45° field of view: 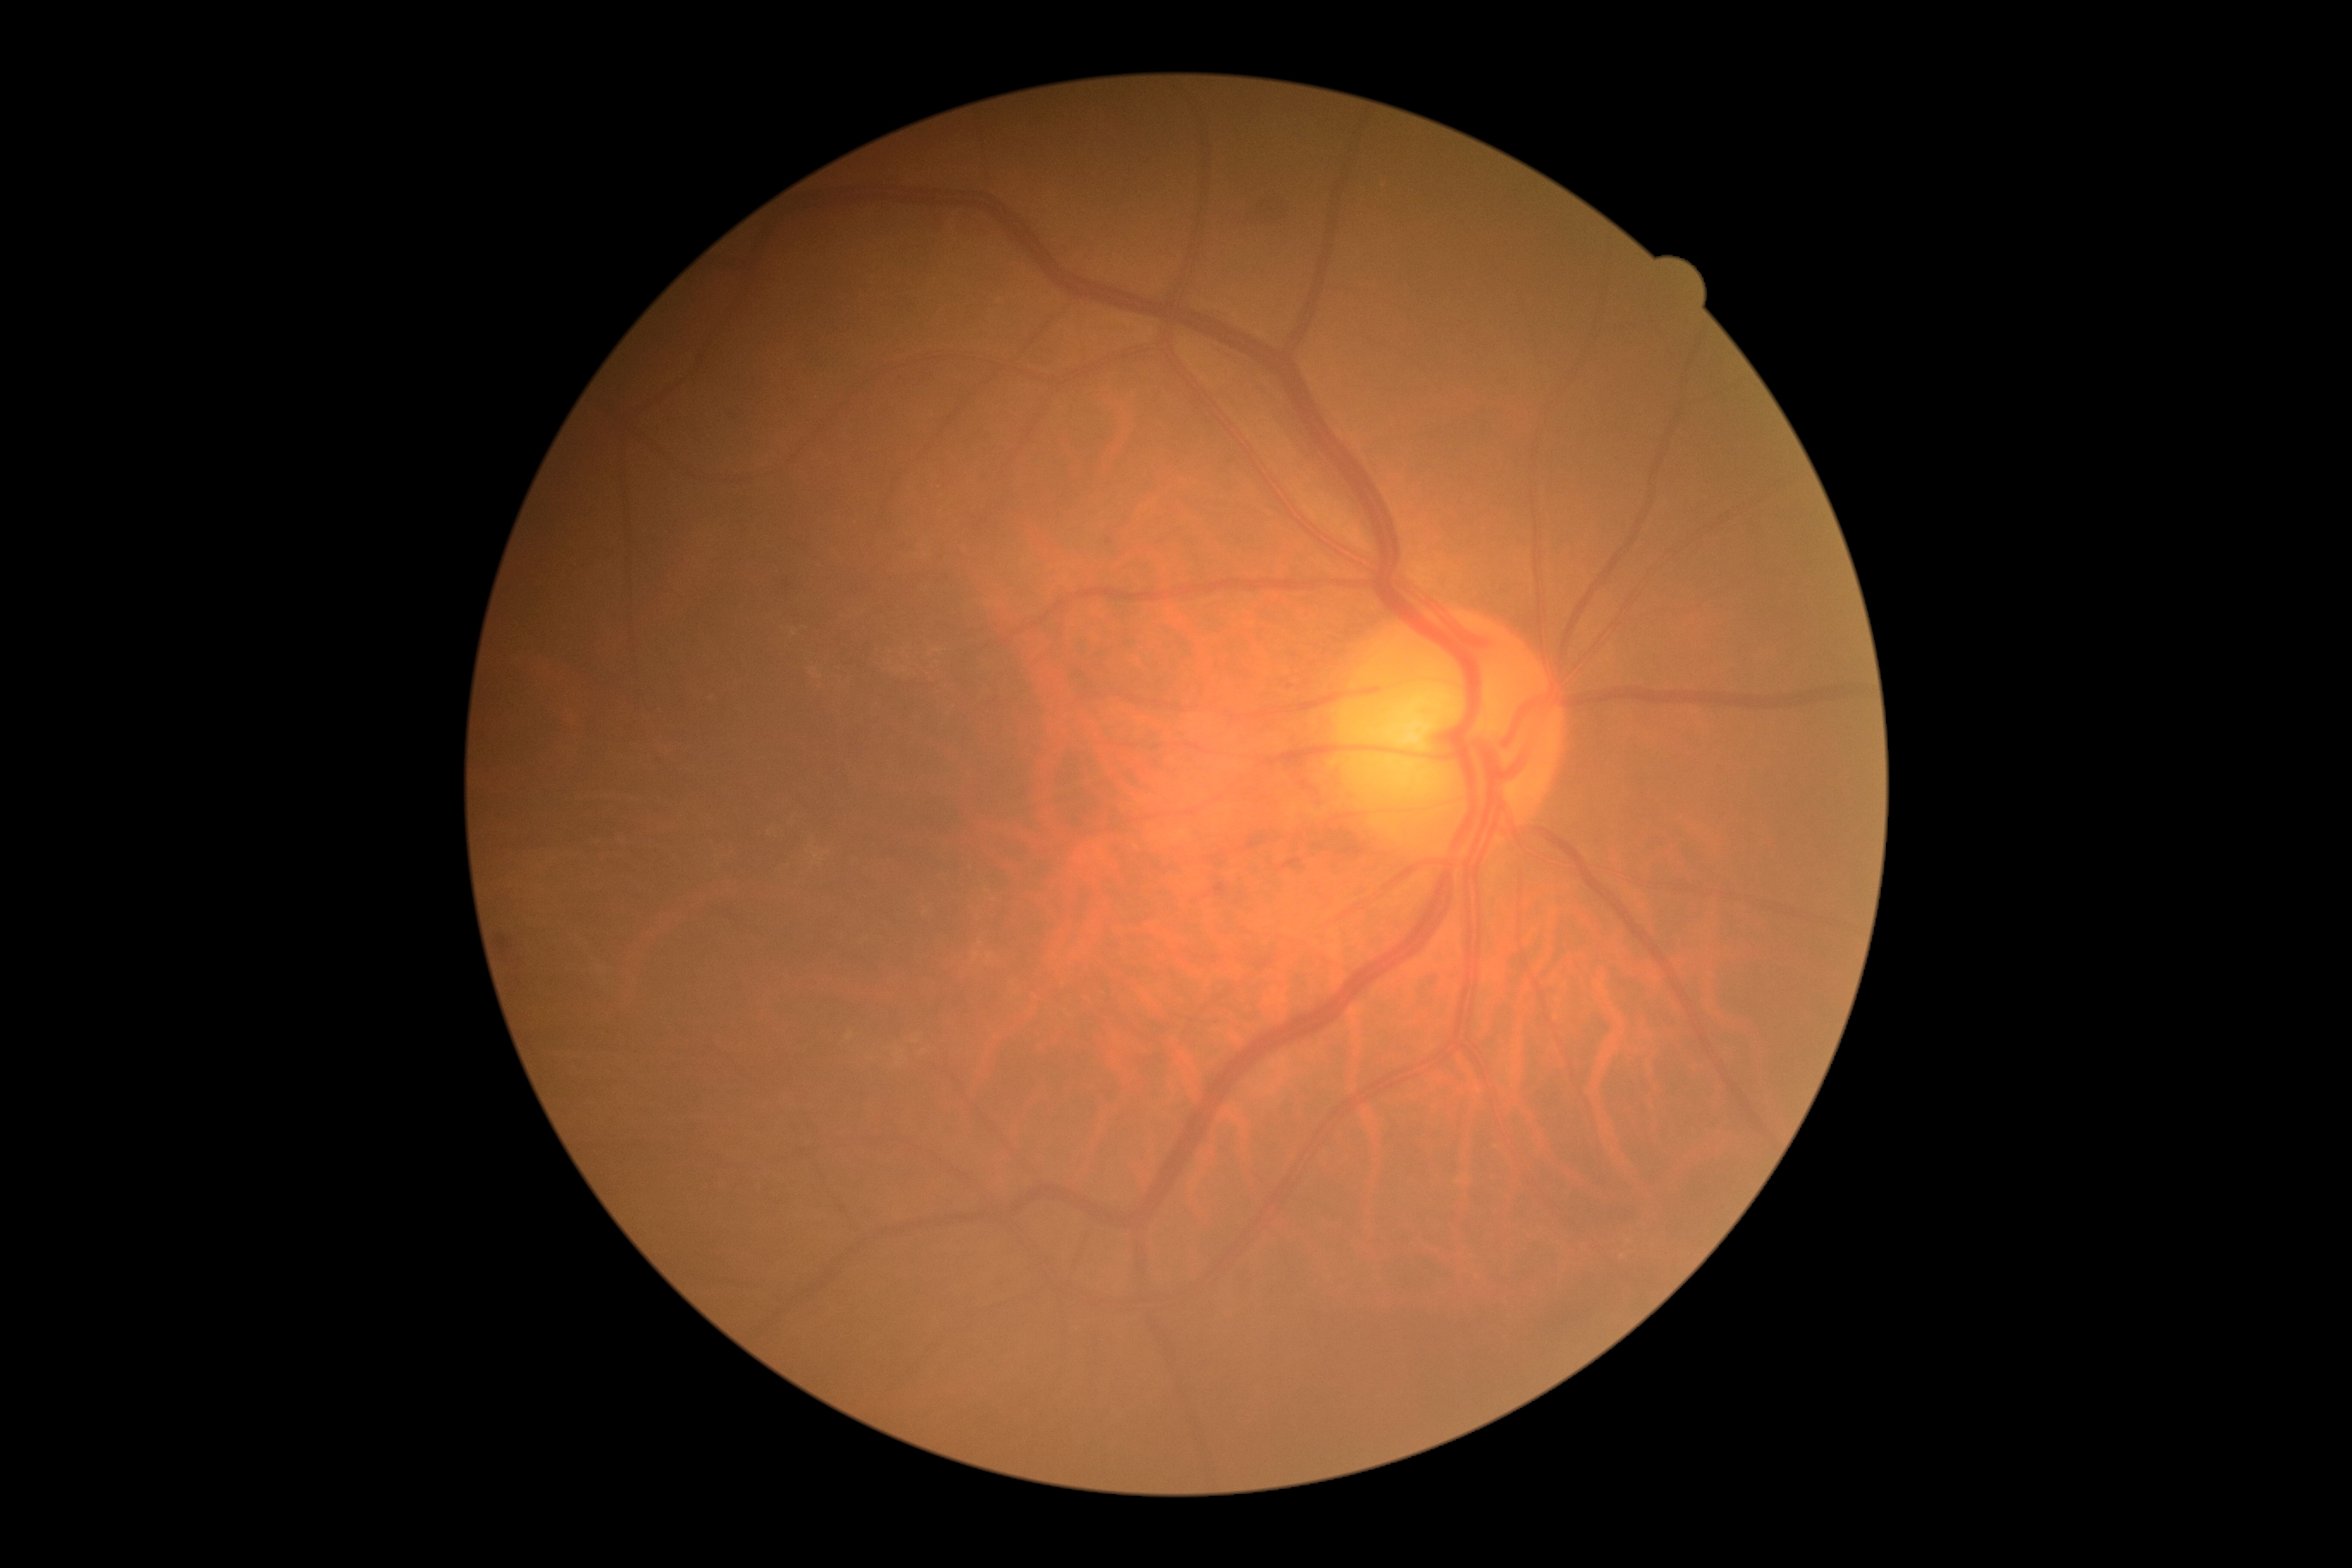

Findings:
* diabetic retinopathy grade — 2 (moderate NPDR)
* DR class — non-proliferative diabetic retinopathy